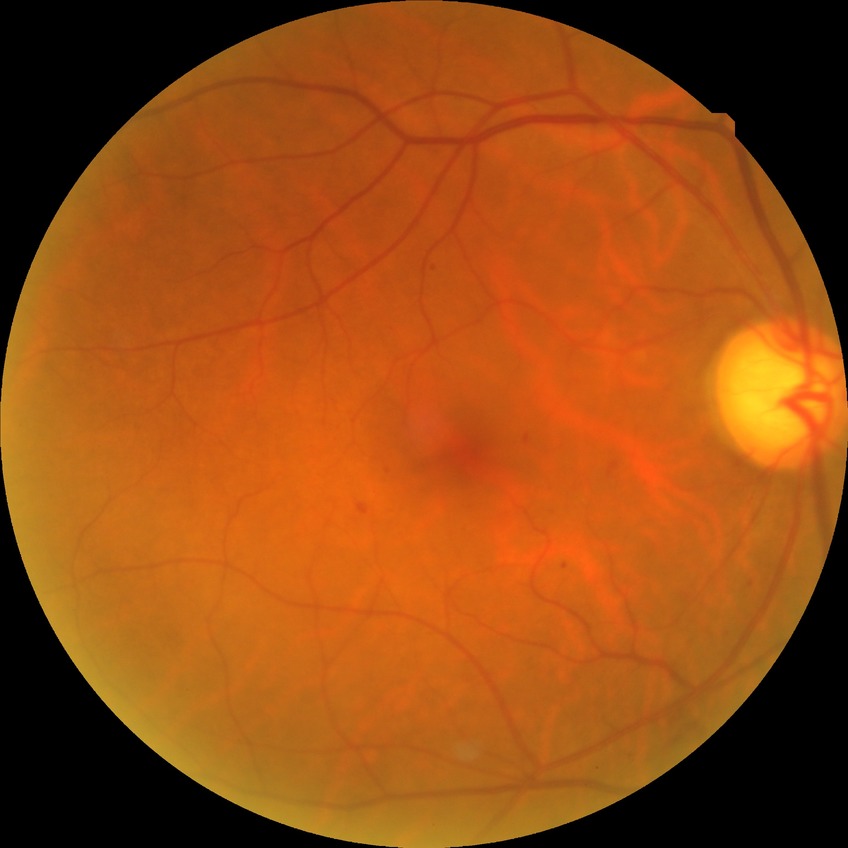 {"davis_grade": "simple diabetic retinopathy (SDR)"}